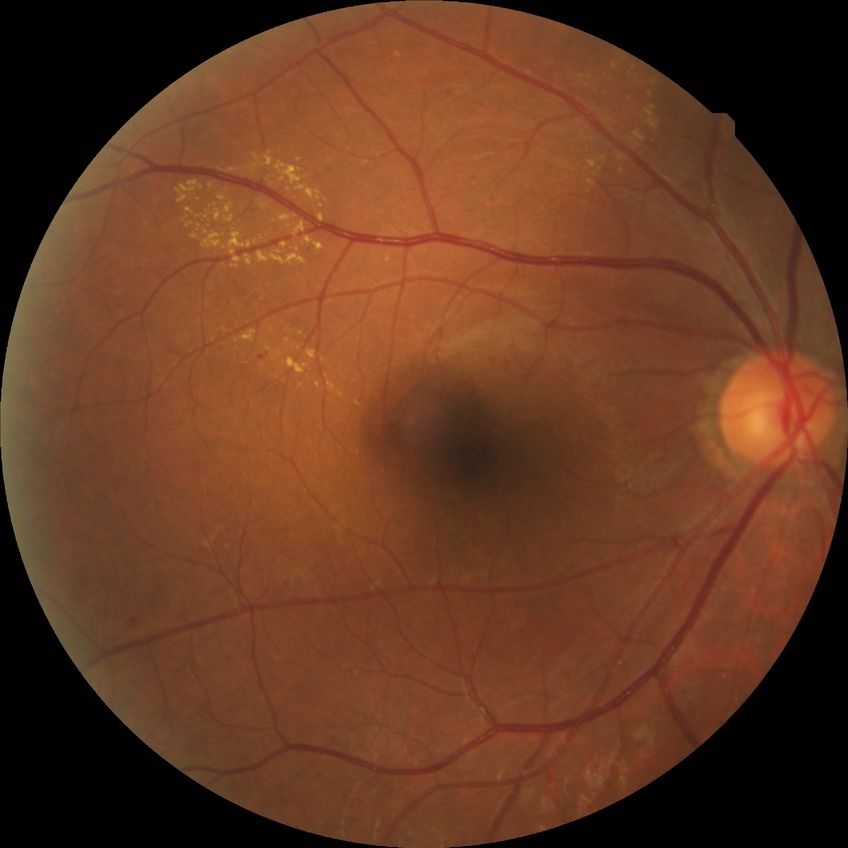
retinopathy grade@pre-proliferative diabetic retinopathy, DR class@non-proliferative diabetic retinopathy.